640 x 480 pixels · wide-field contact fundus photograph of an infant · Clarity RetCam 3, 130° FOV:
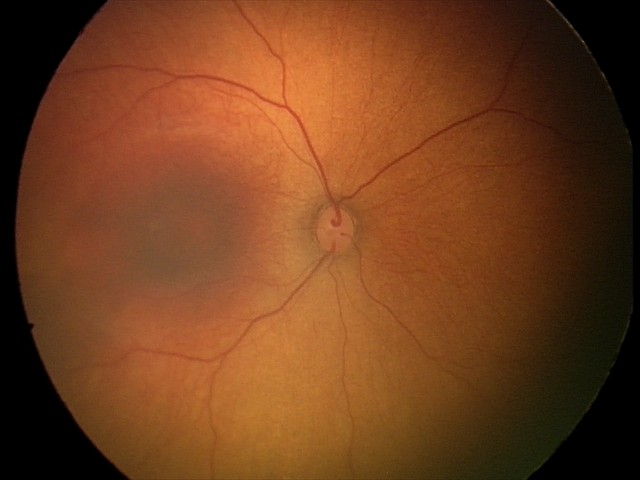
Assessment: normal fundus examination.